2352 x 1568 pixels: 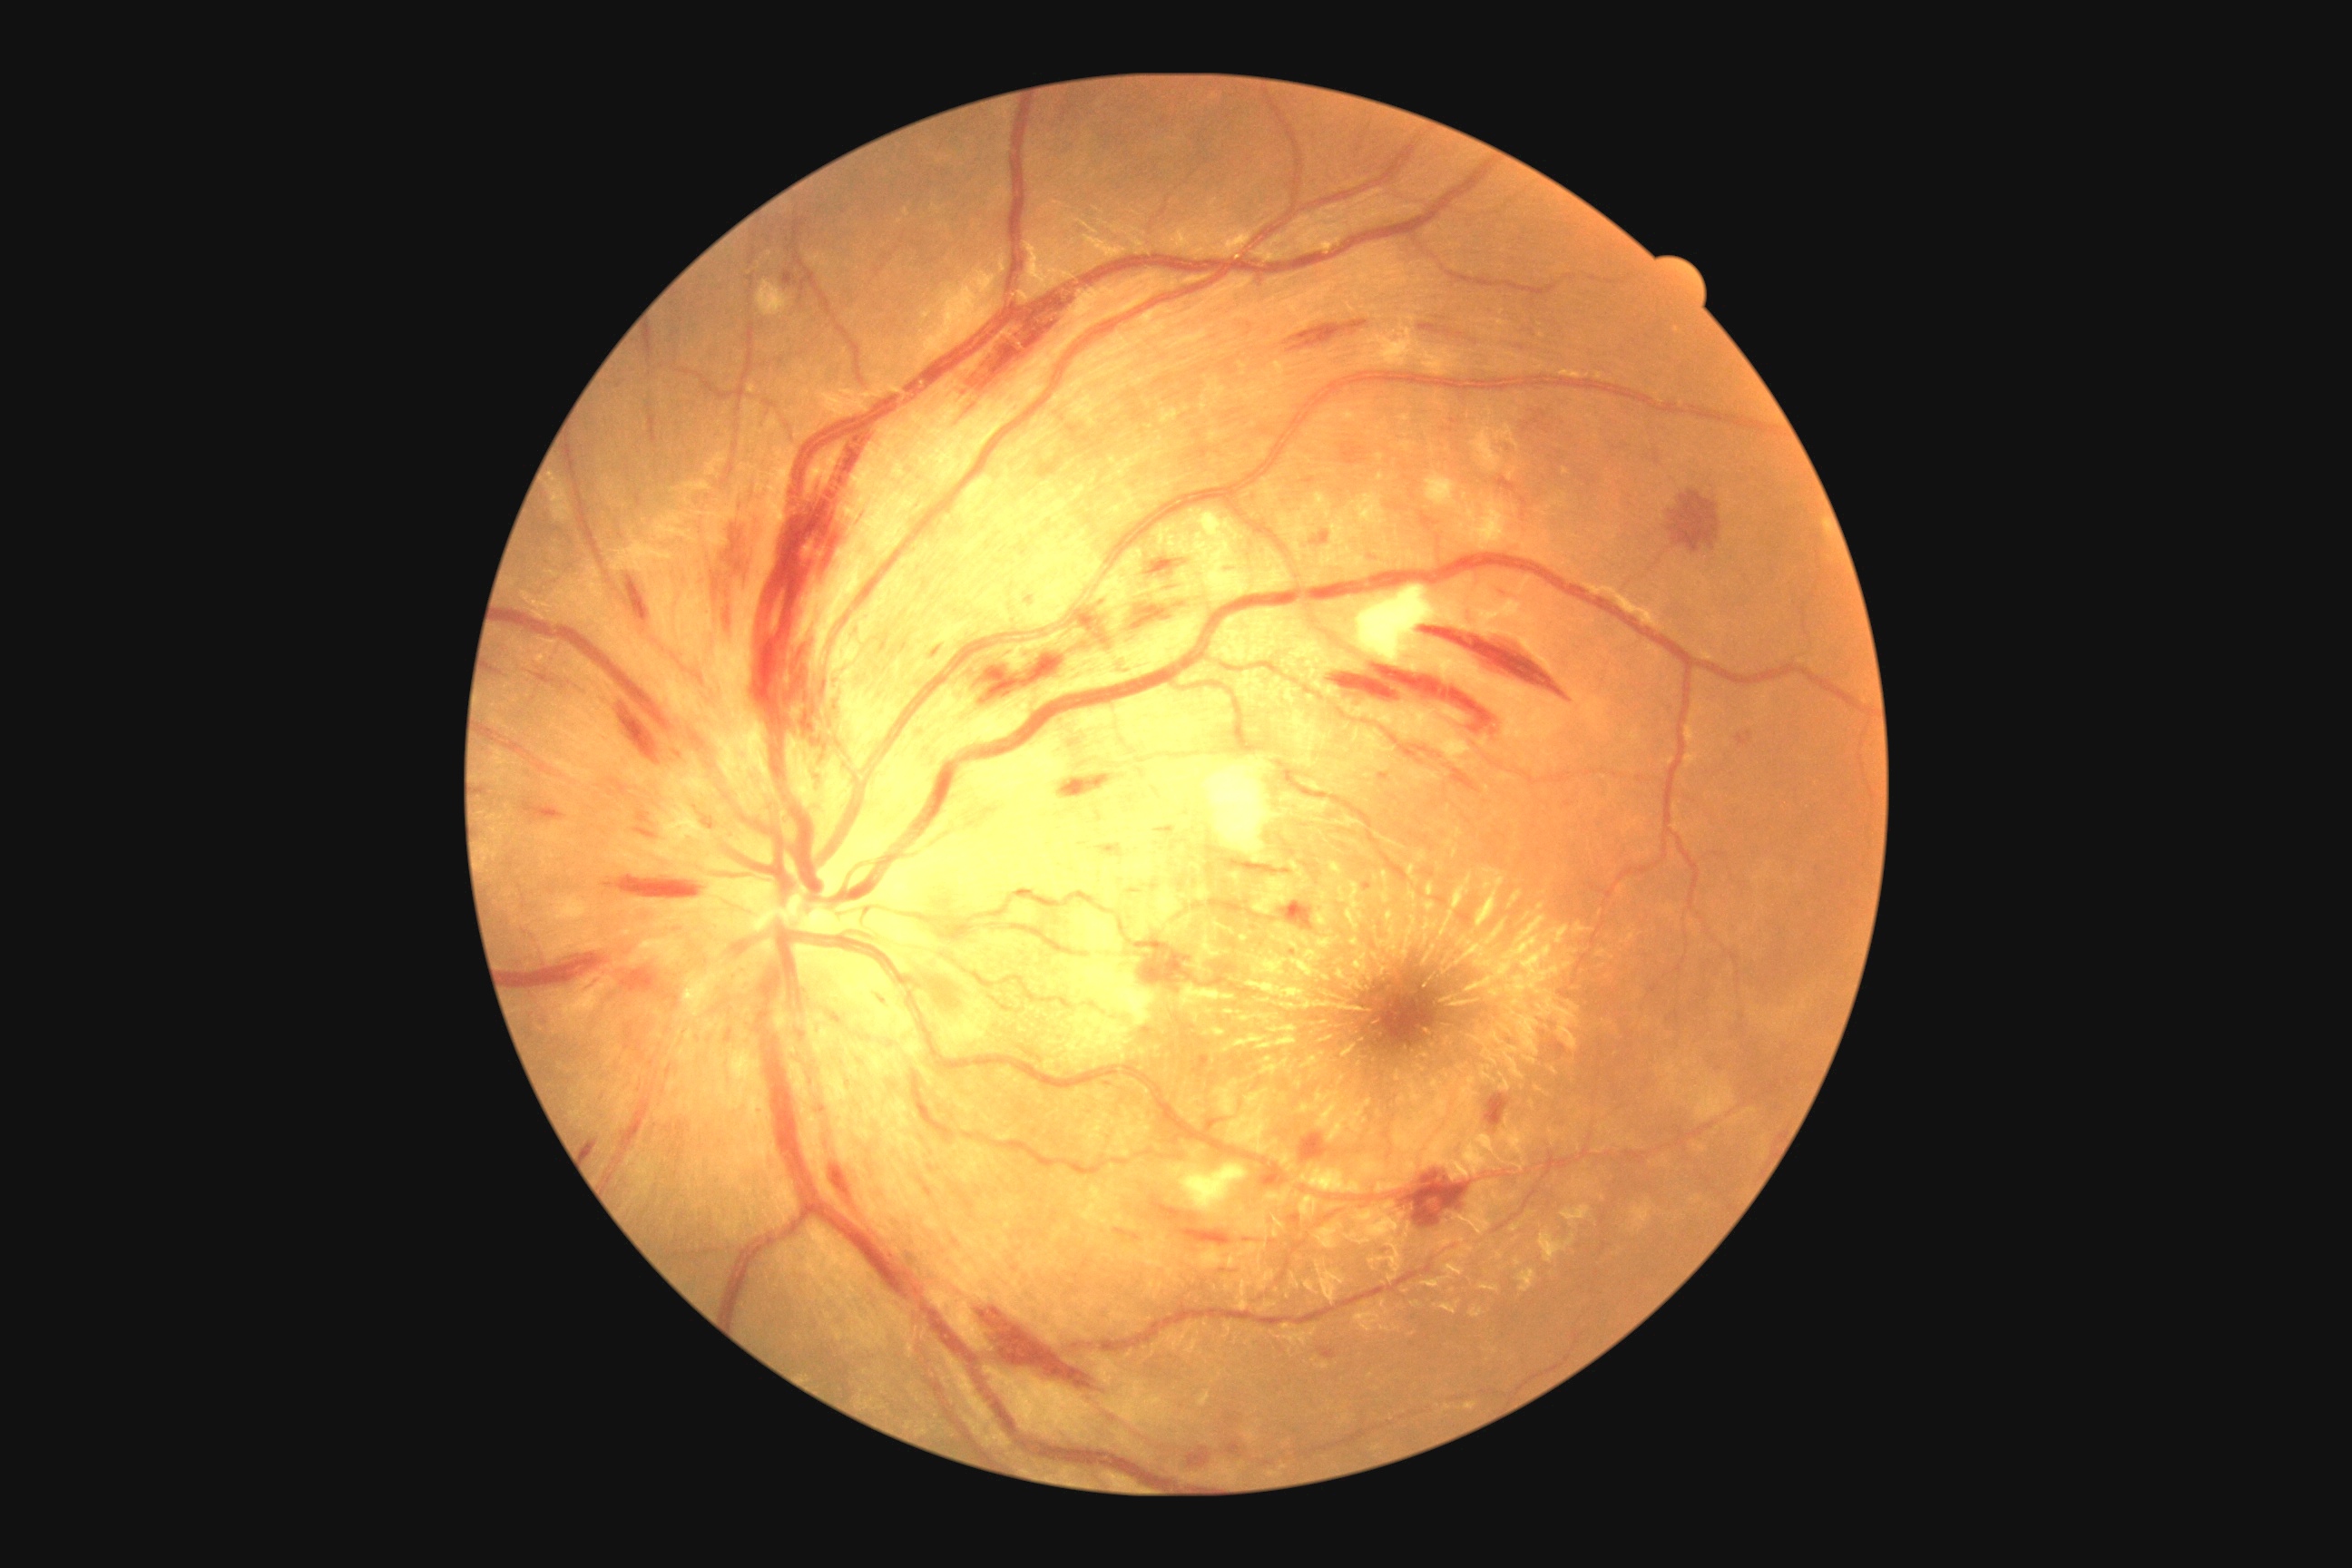 DR stage = grade 2 (moderate NPDR).